848x848px · 45-degree field of view · acquired with a NIDEK AFC-230 · without pupil dilation — 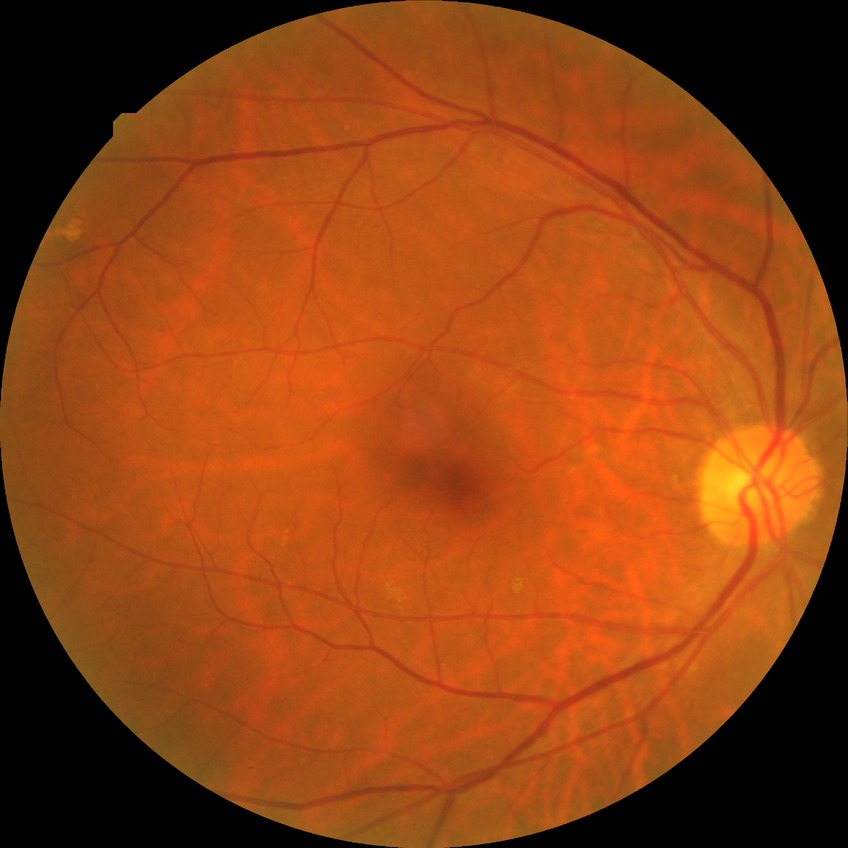 Diabetic retinopathy (DR): no diabetic retinopathy (NDR).